Color fundus image. 45-degree field of view
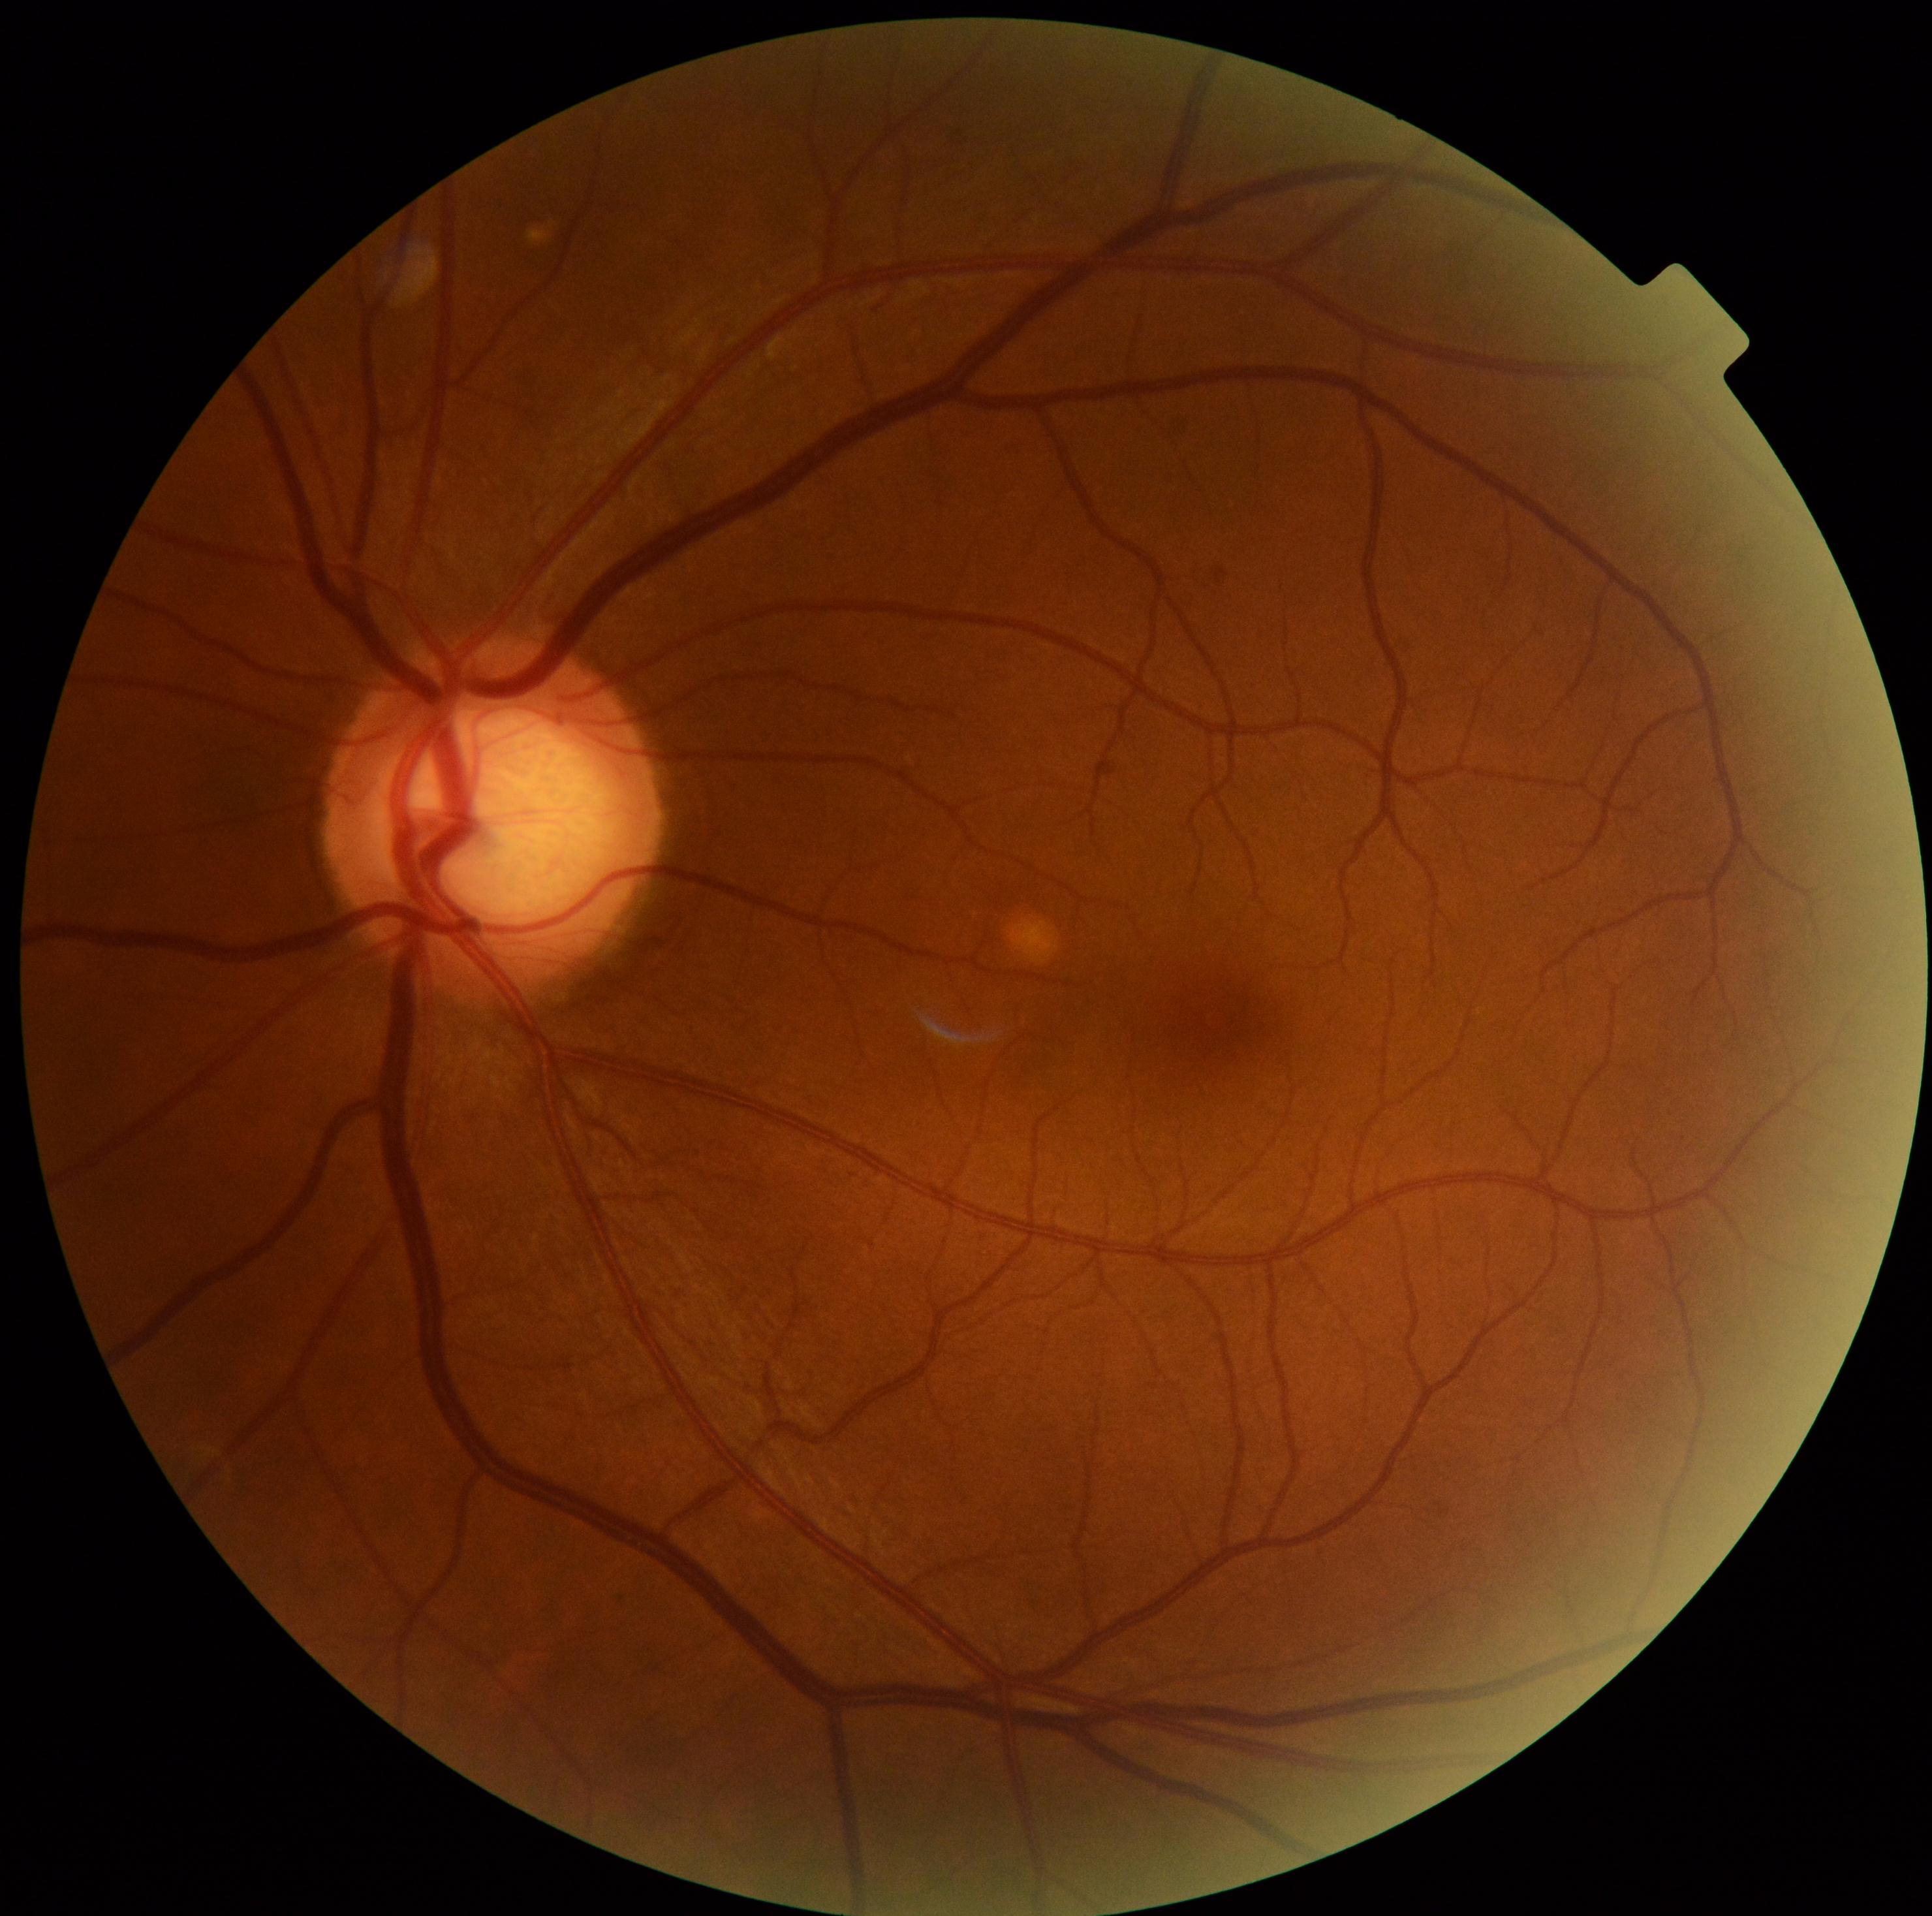 DR severity is grade 0.